Wide-field fundus image from infant ROP screening; camera: Clarity RetCam 3 (130° FOV):
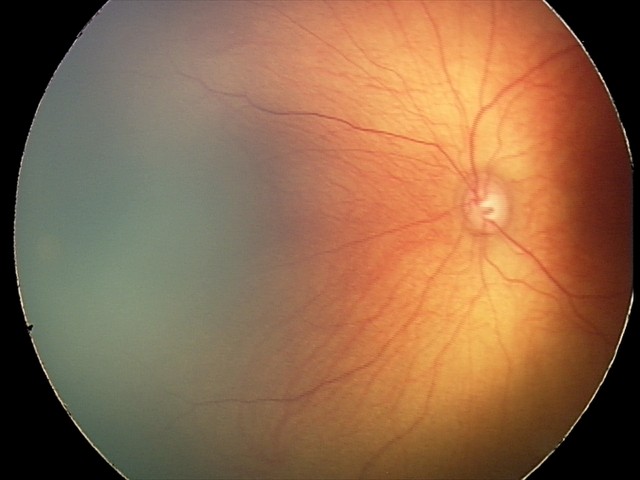
No retinal pathology identified on screening.